Phoenix ICON, 100° FOV; 1240x1240px; wide-field fundus image from infant ROP screening.
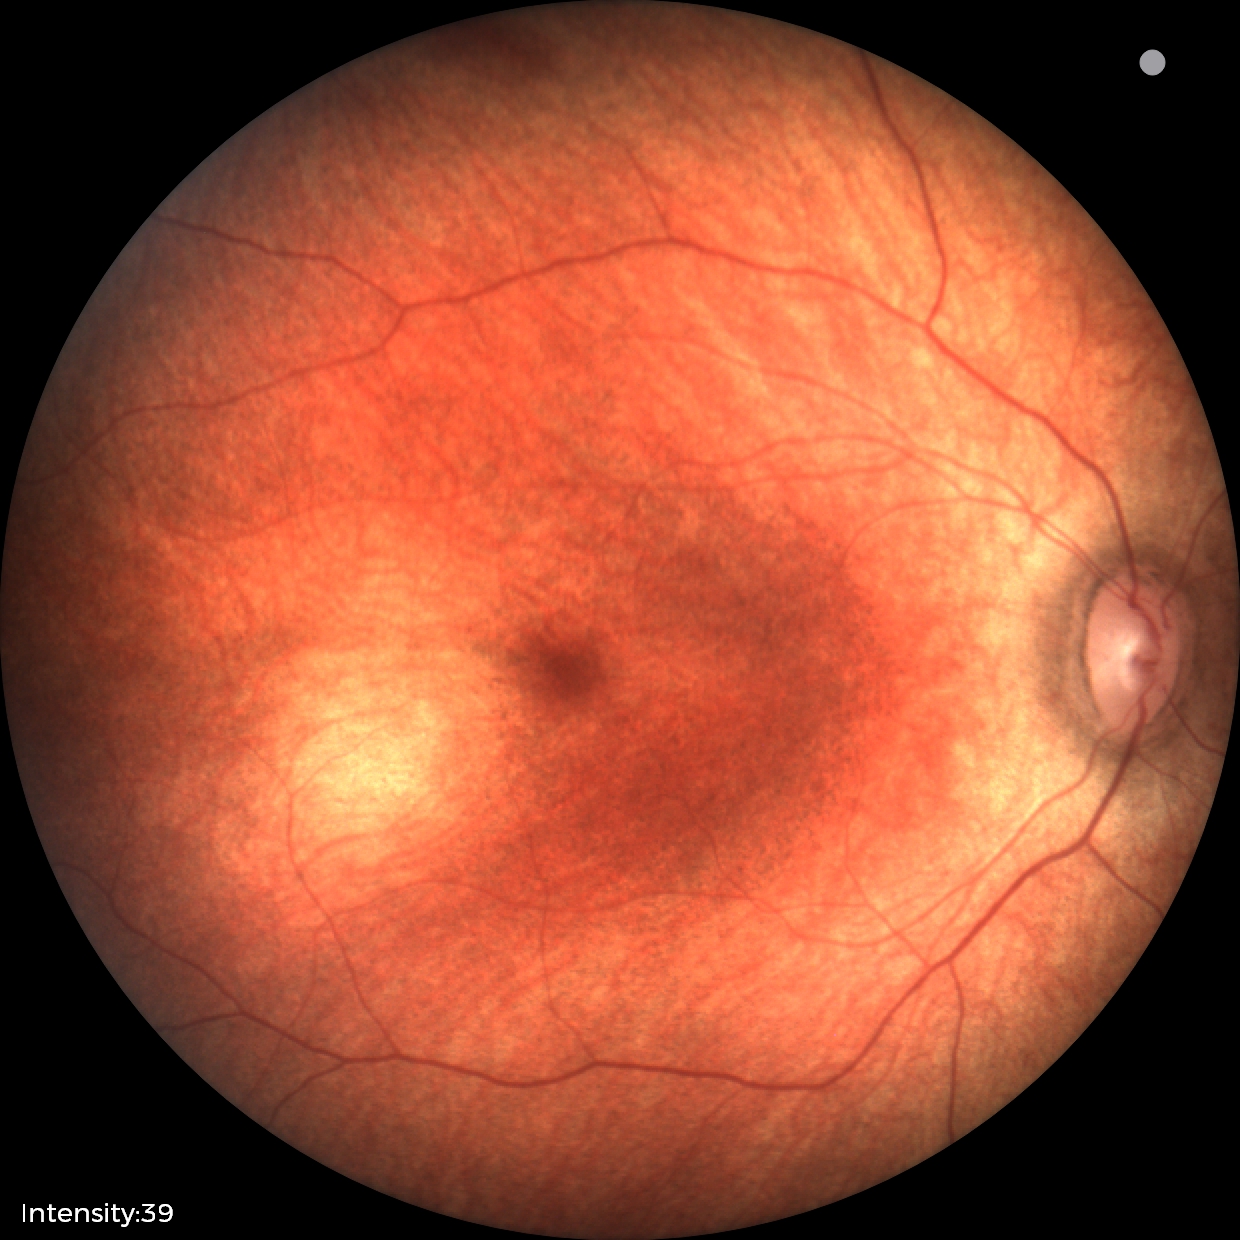 Impression = normal.